130° field of view (Natus RetCam Envision); infant wide-field fundus photograph; image size 1440x1080: 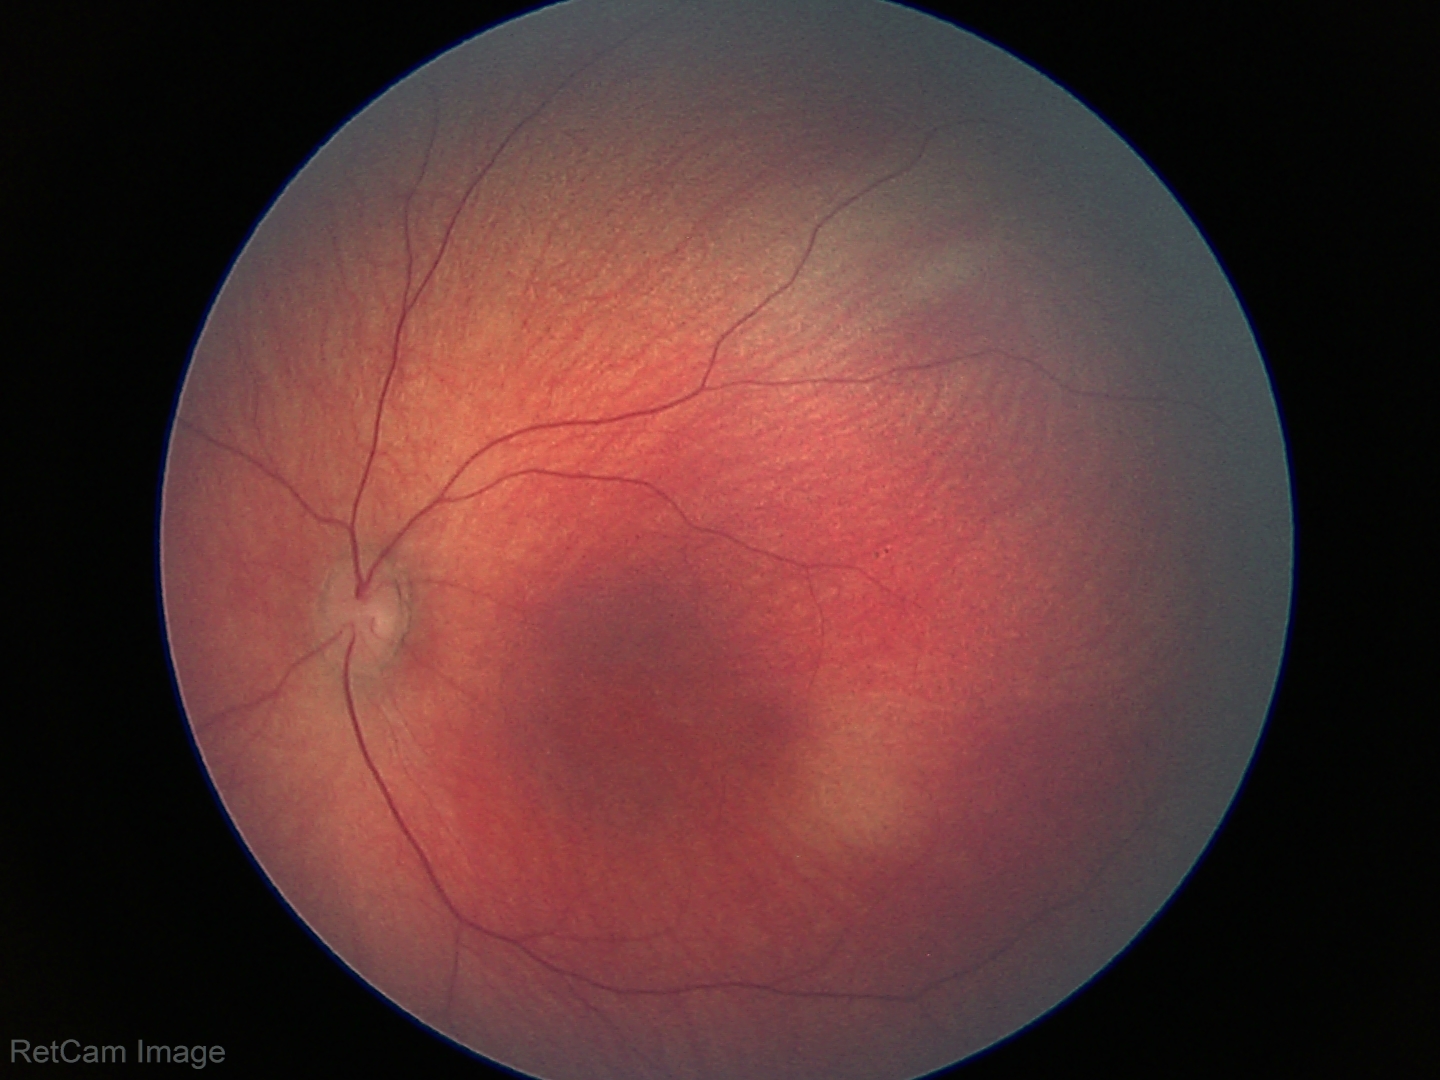 Assessment: no pathology identified.